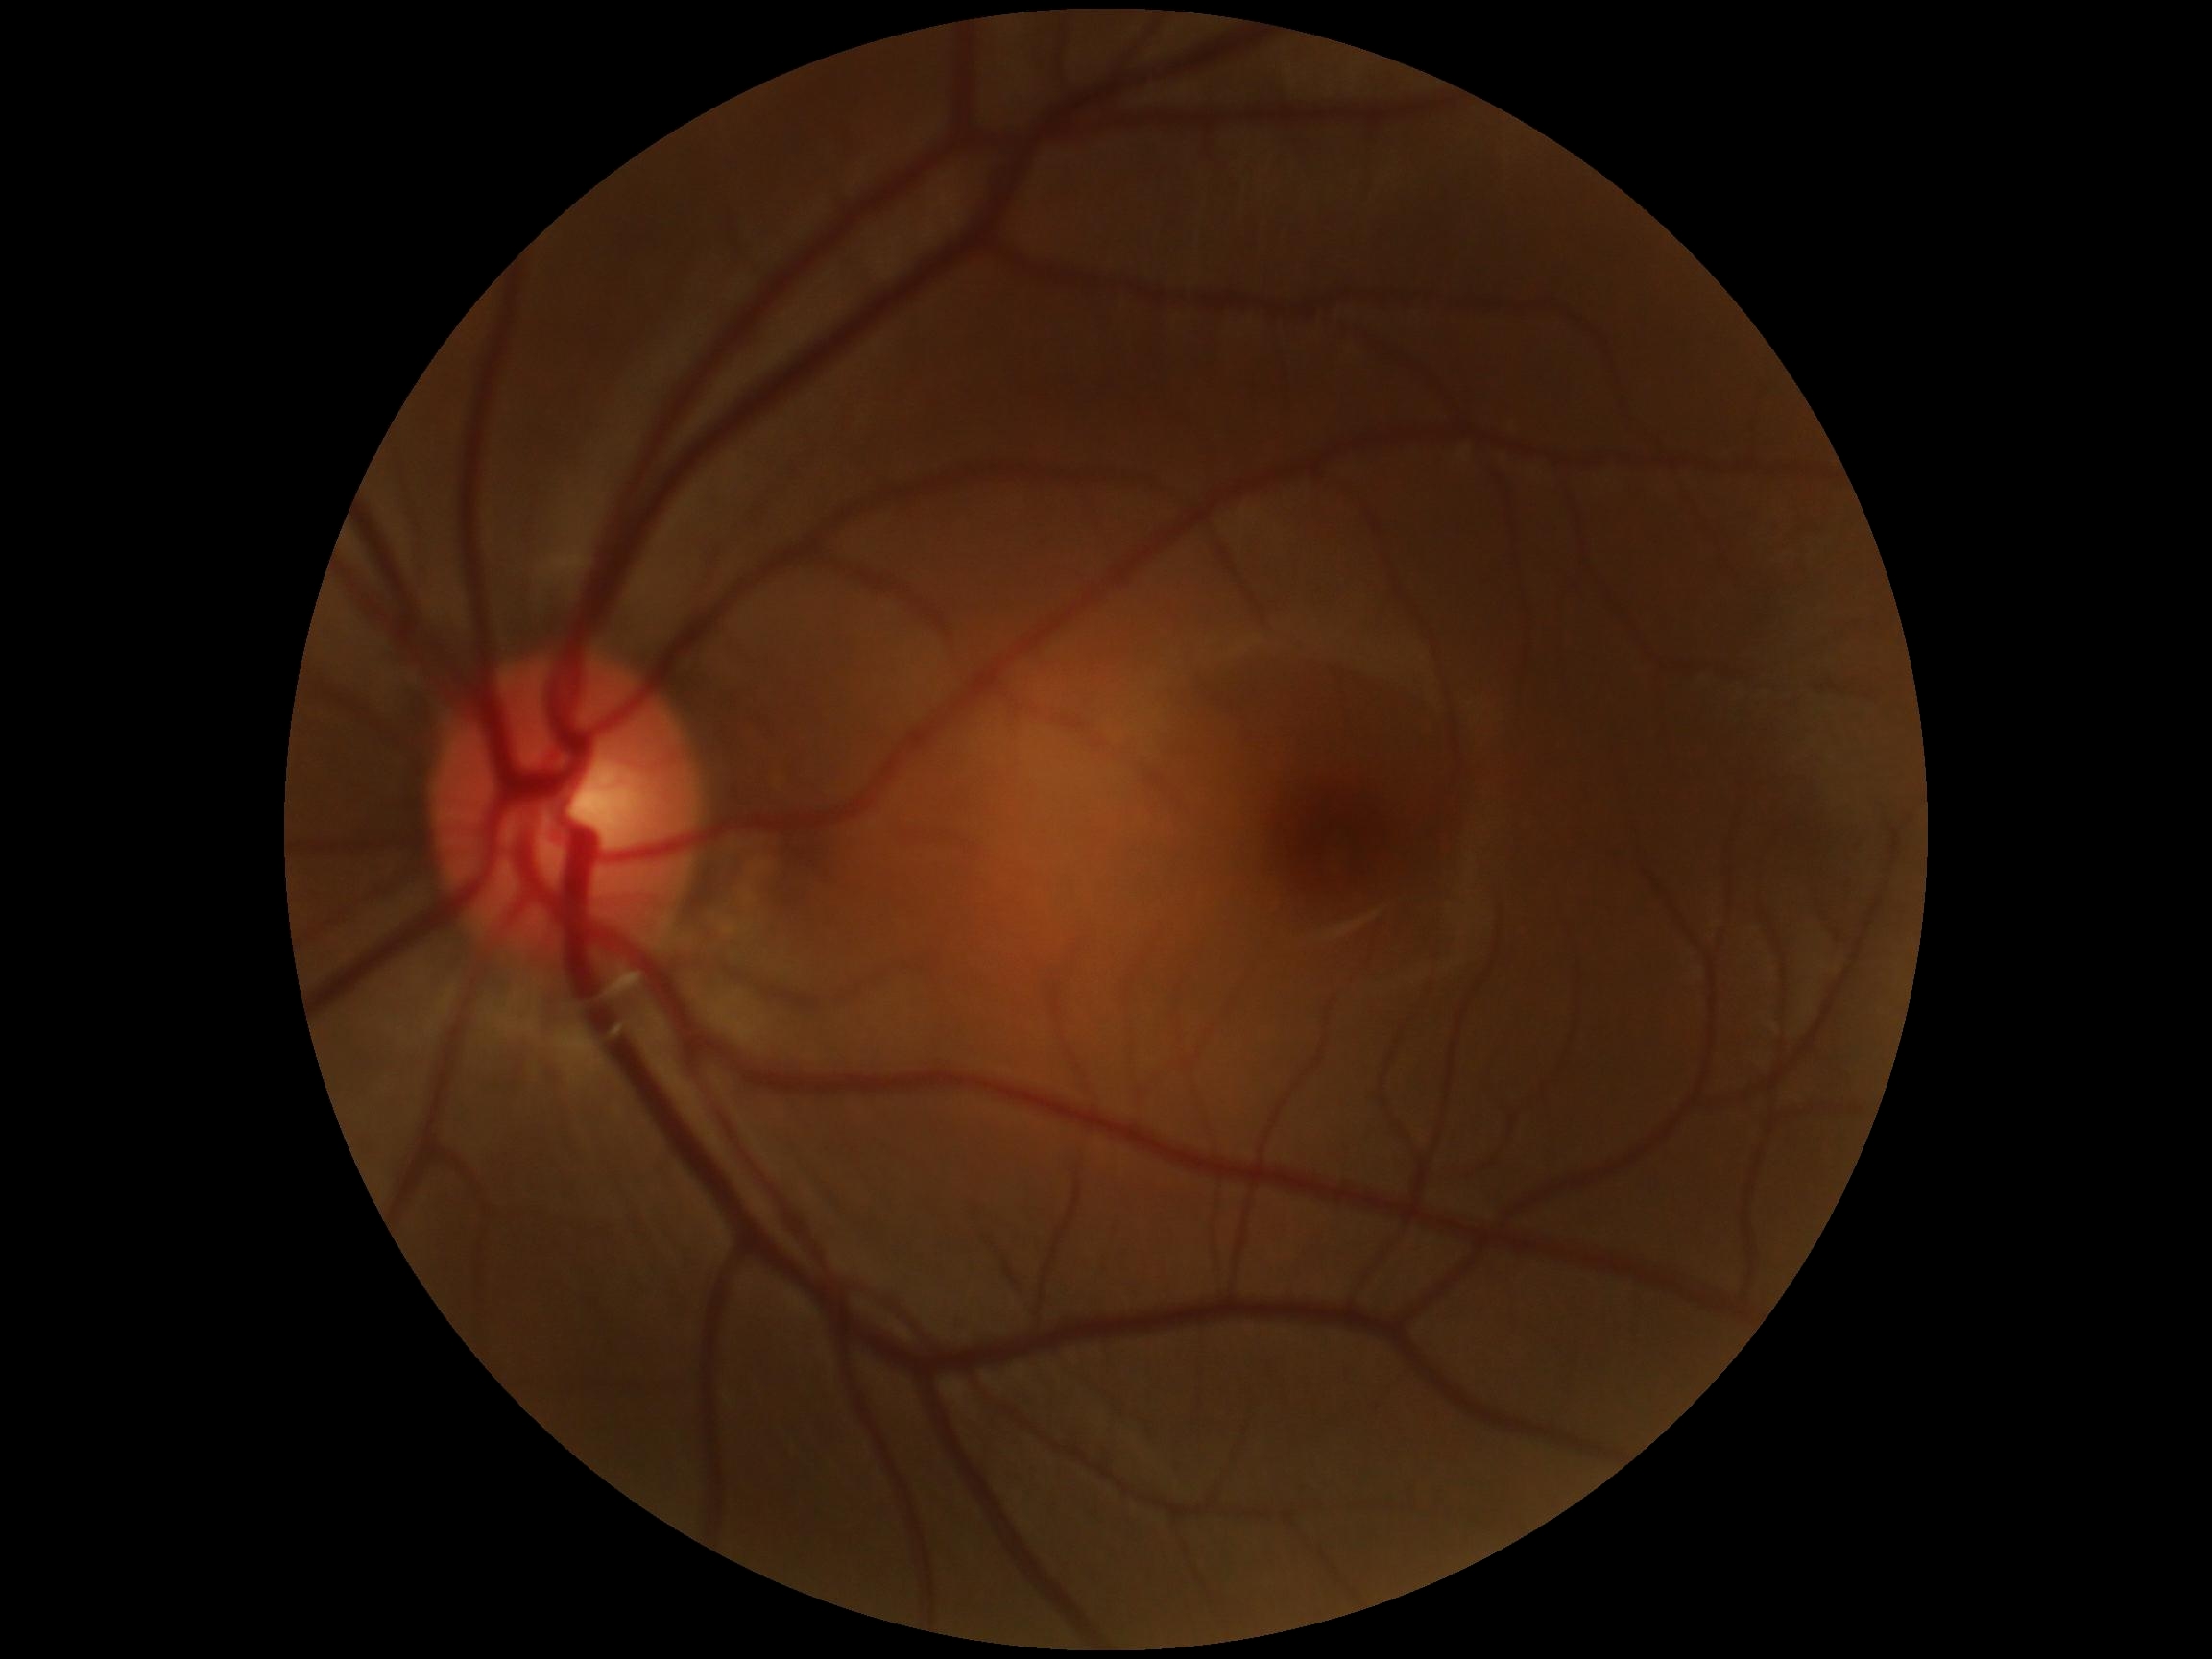
Annotations:
* DR impression: no apparent DR
* diabetic retinopathy severity: grade 0 (no apparent retinopathy)